Posterior pole photograph. FOV: 45 degrees — 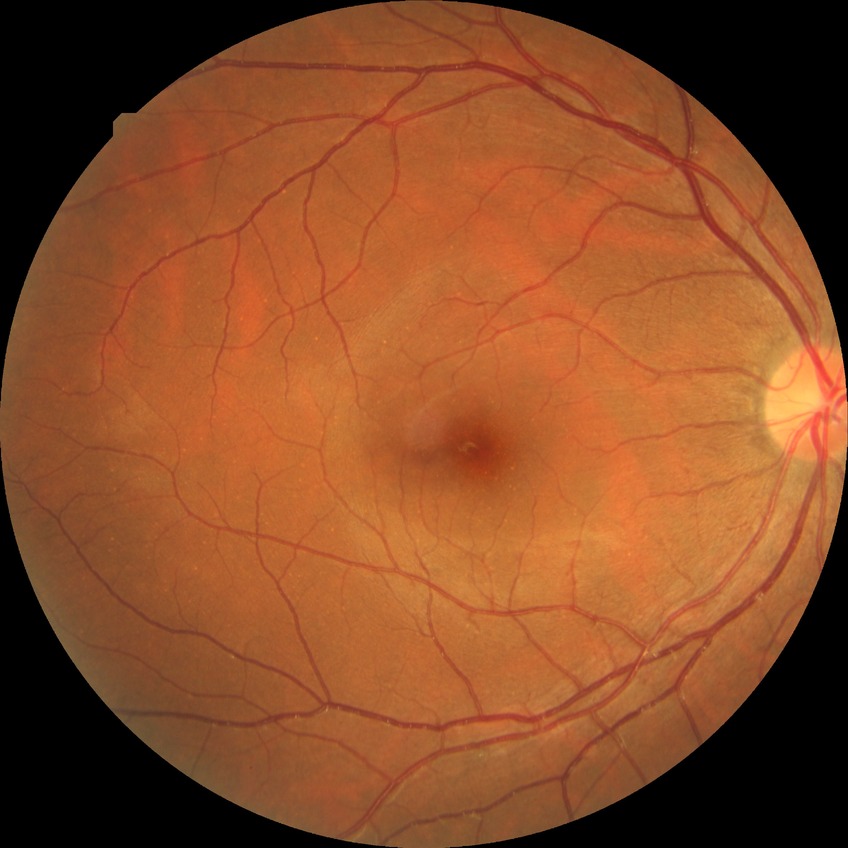
diabetic retinopathy (DR)@NDR (no diabetic retinopathy).